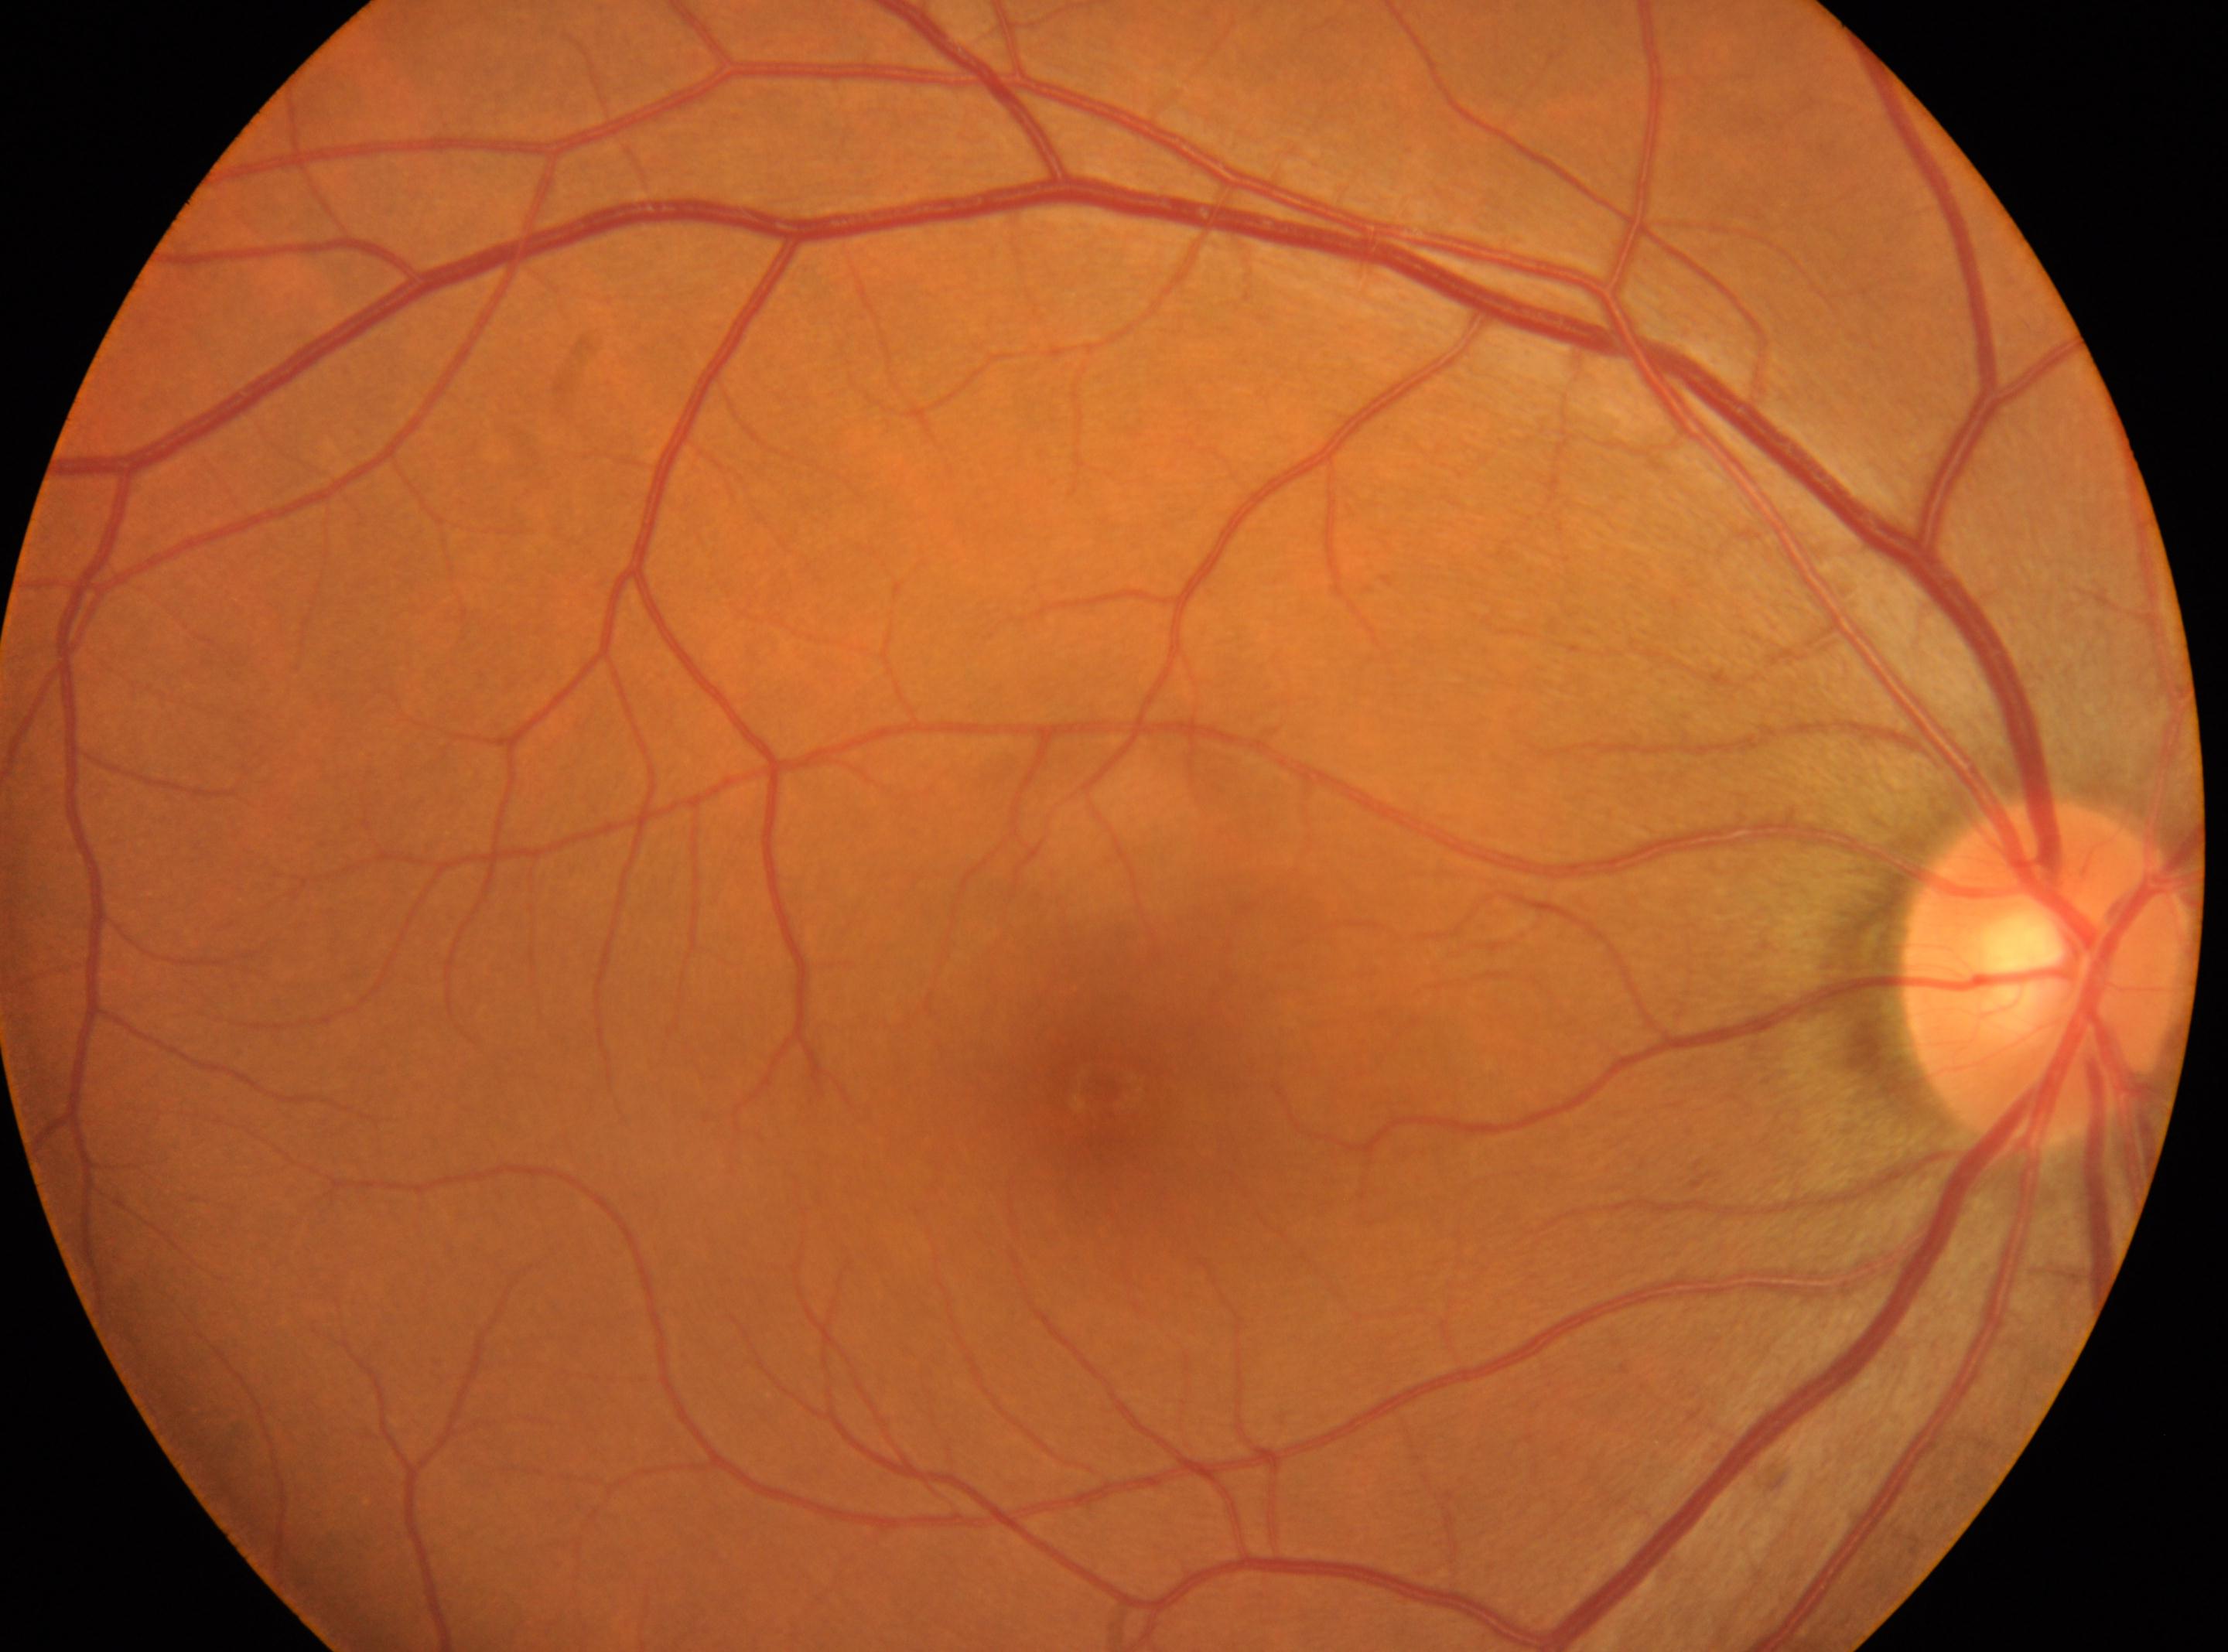

Macular center: (1103, 1087).
DR severity is 0/4.
Eye: OD.
The optic nerve head is at (2047, 972).